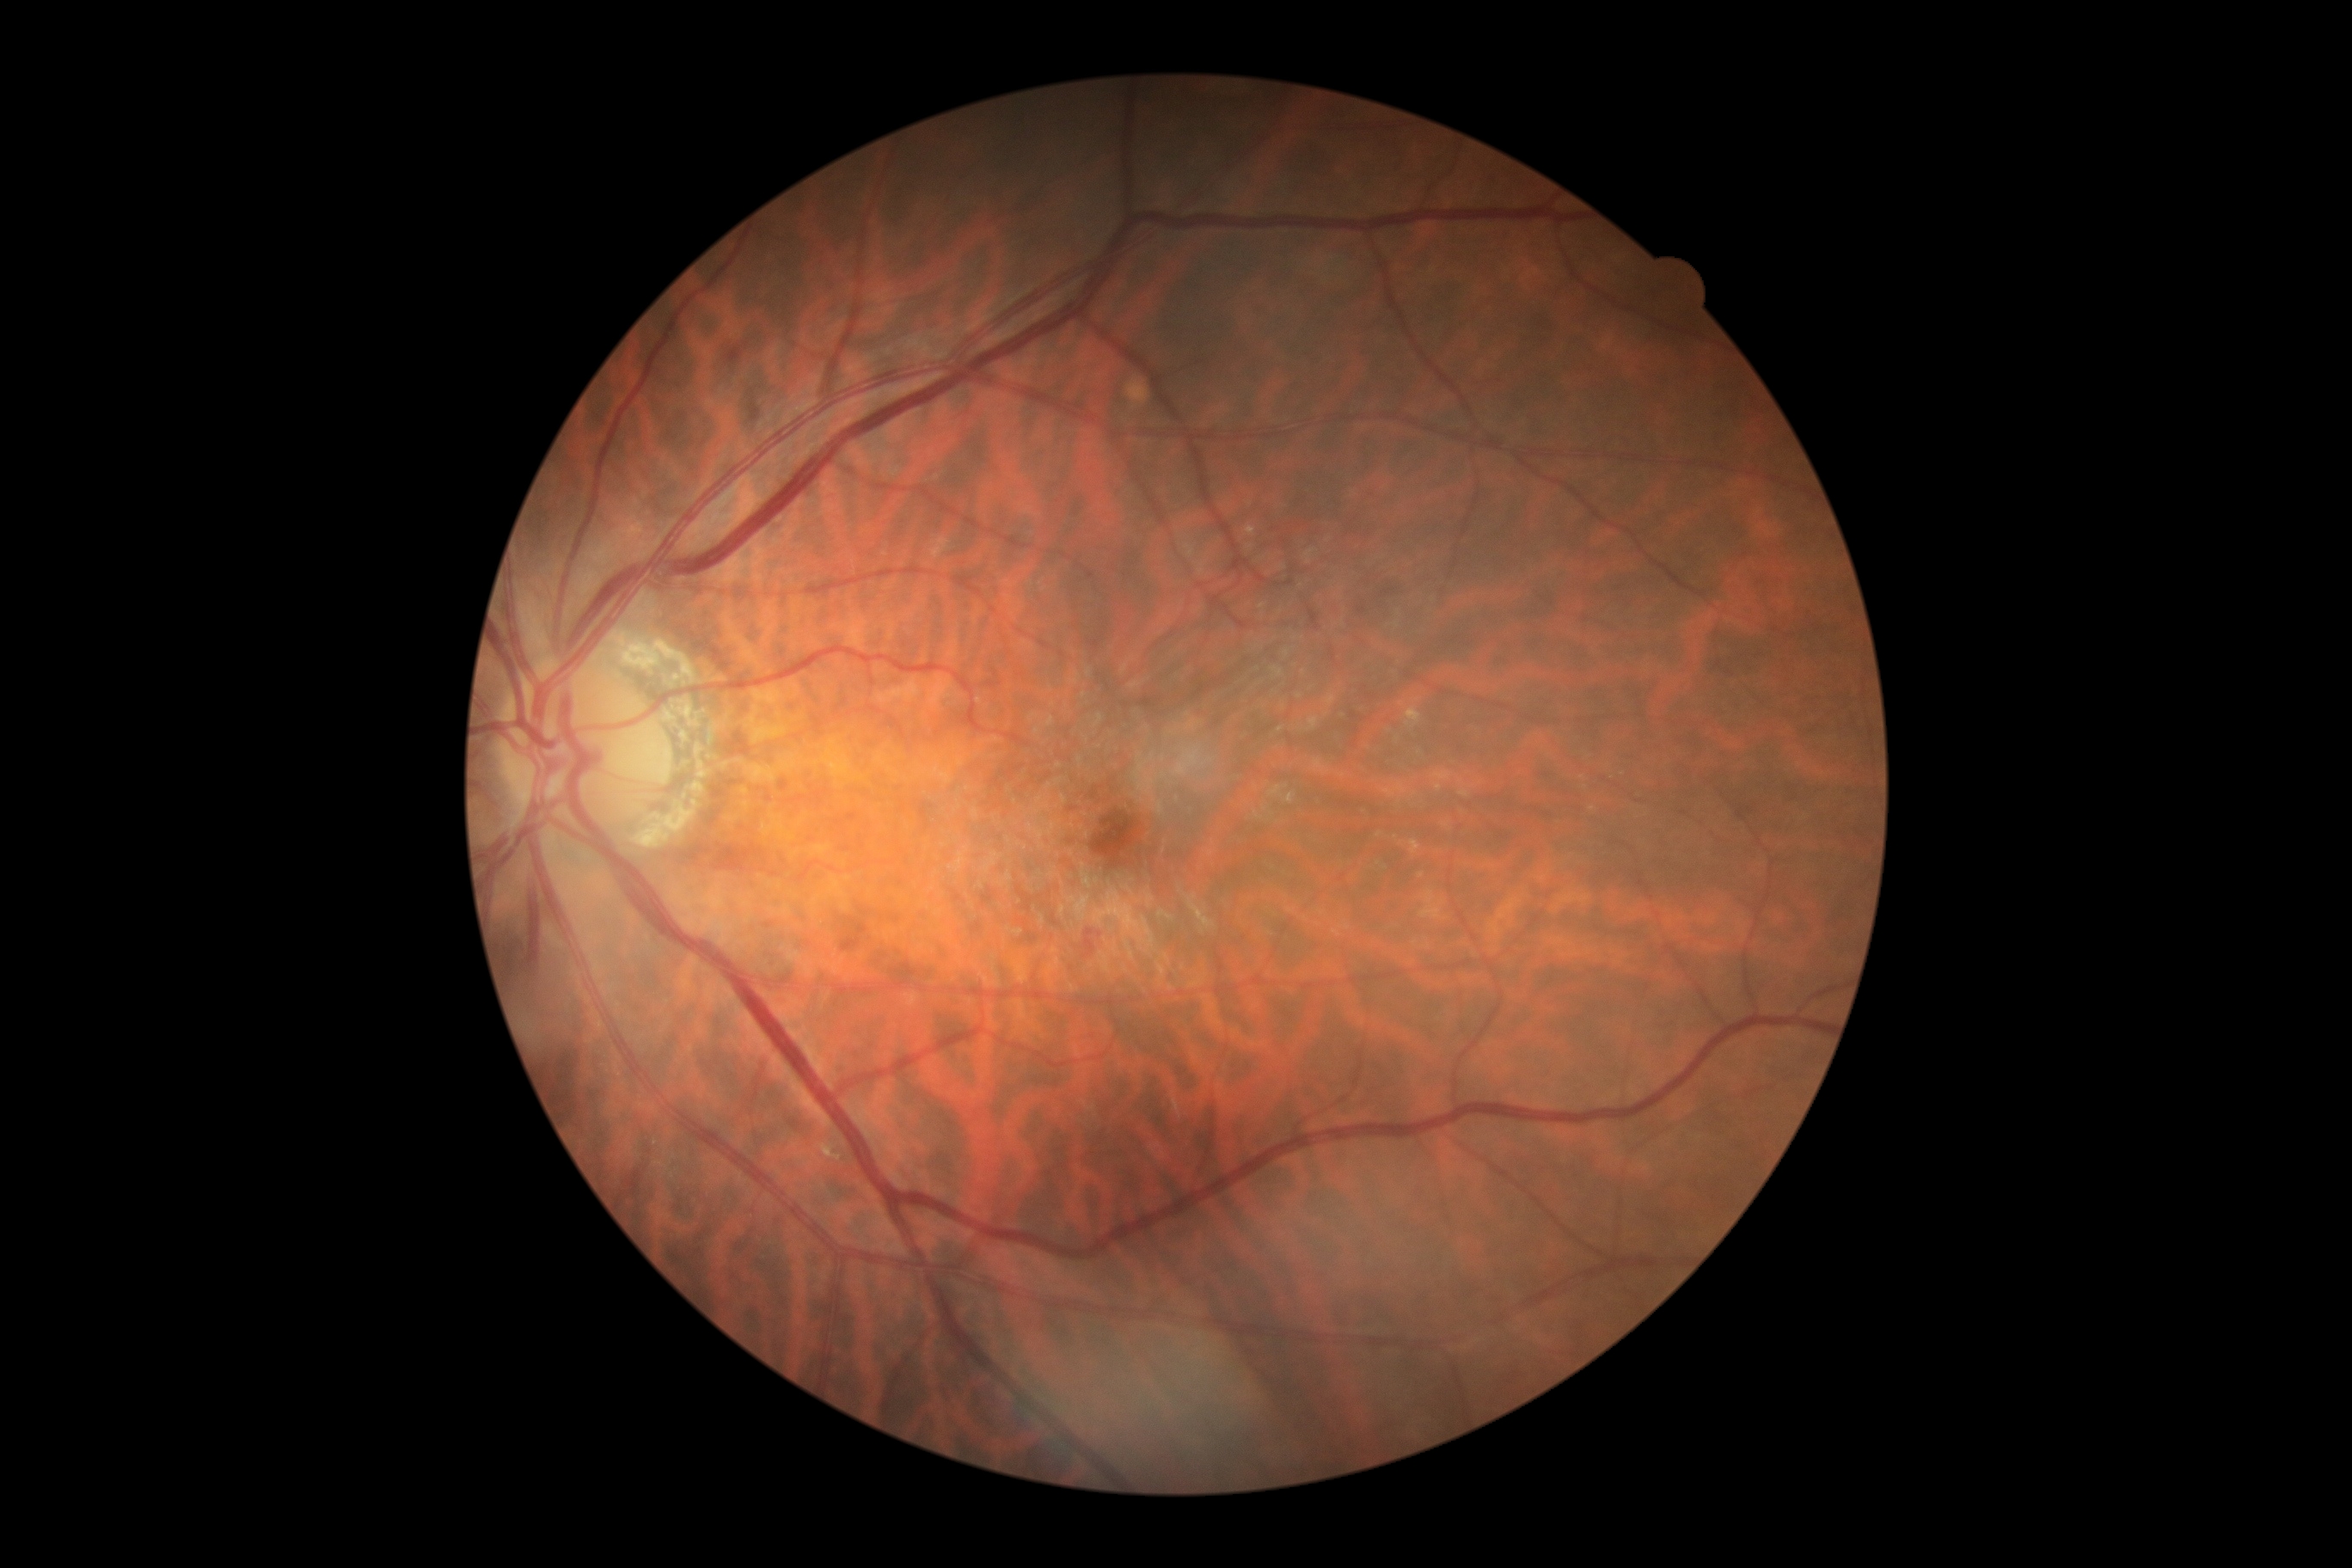
DR severity: 2.